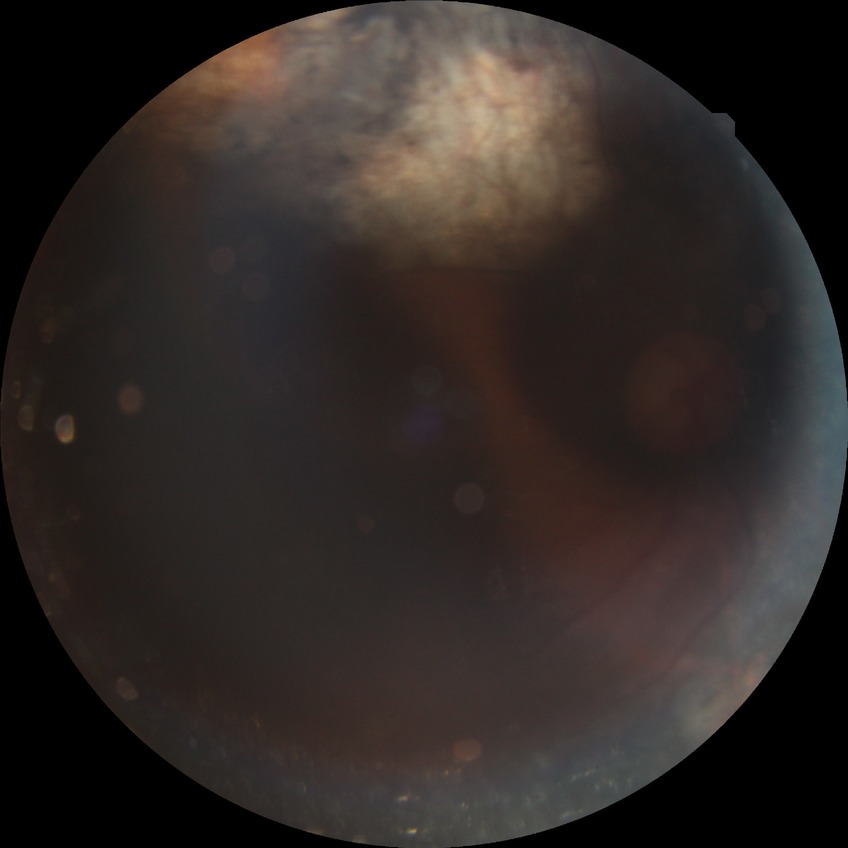

Davis grade is PDR.